Davis DR grading:
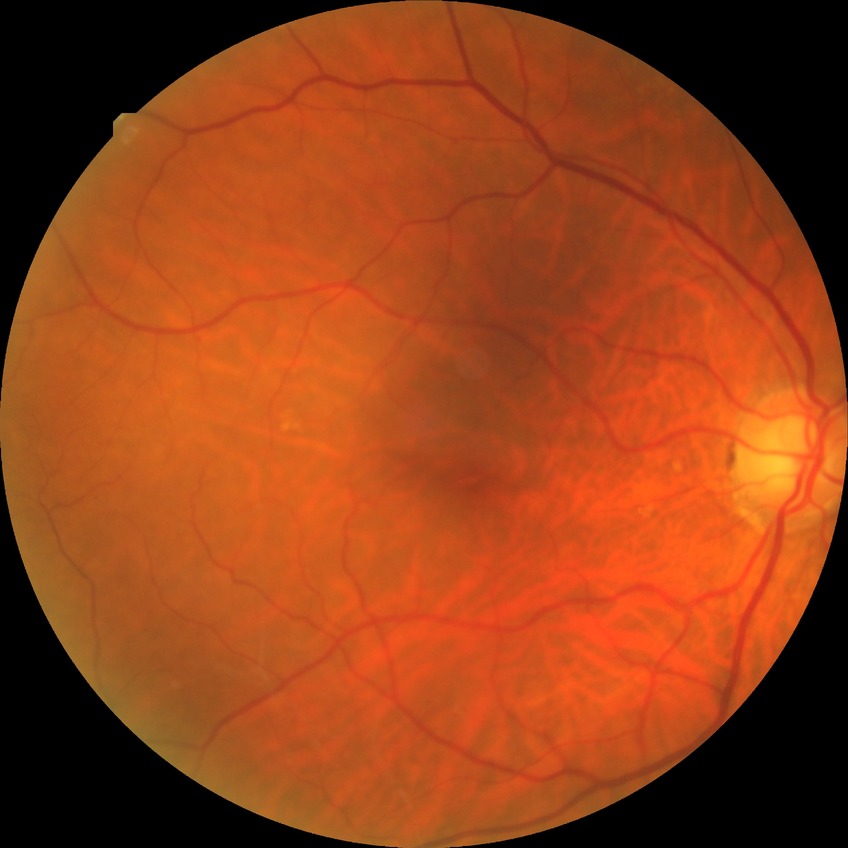

Modified Davis classification: no diabetic retinopathy.